45° FOV · 1932 by 1932 pixels.
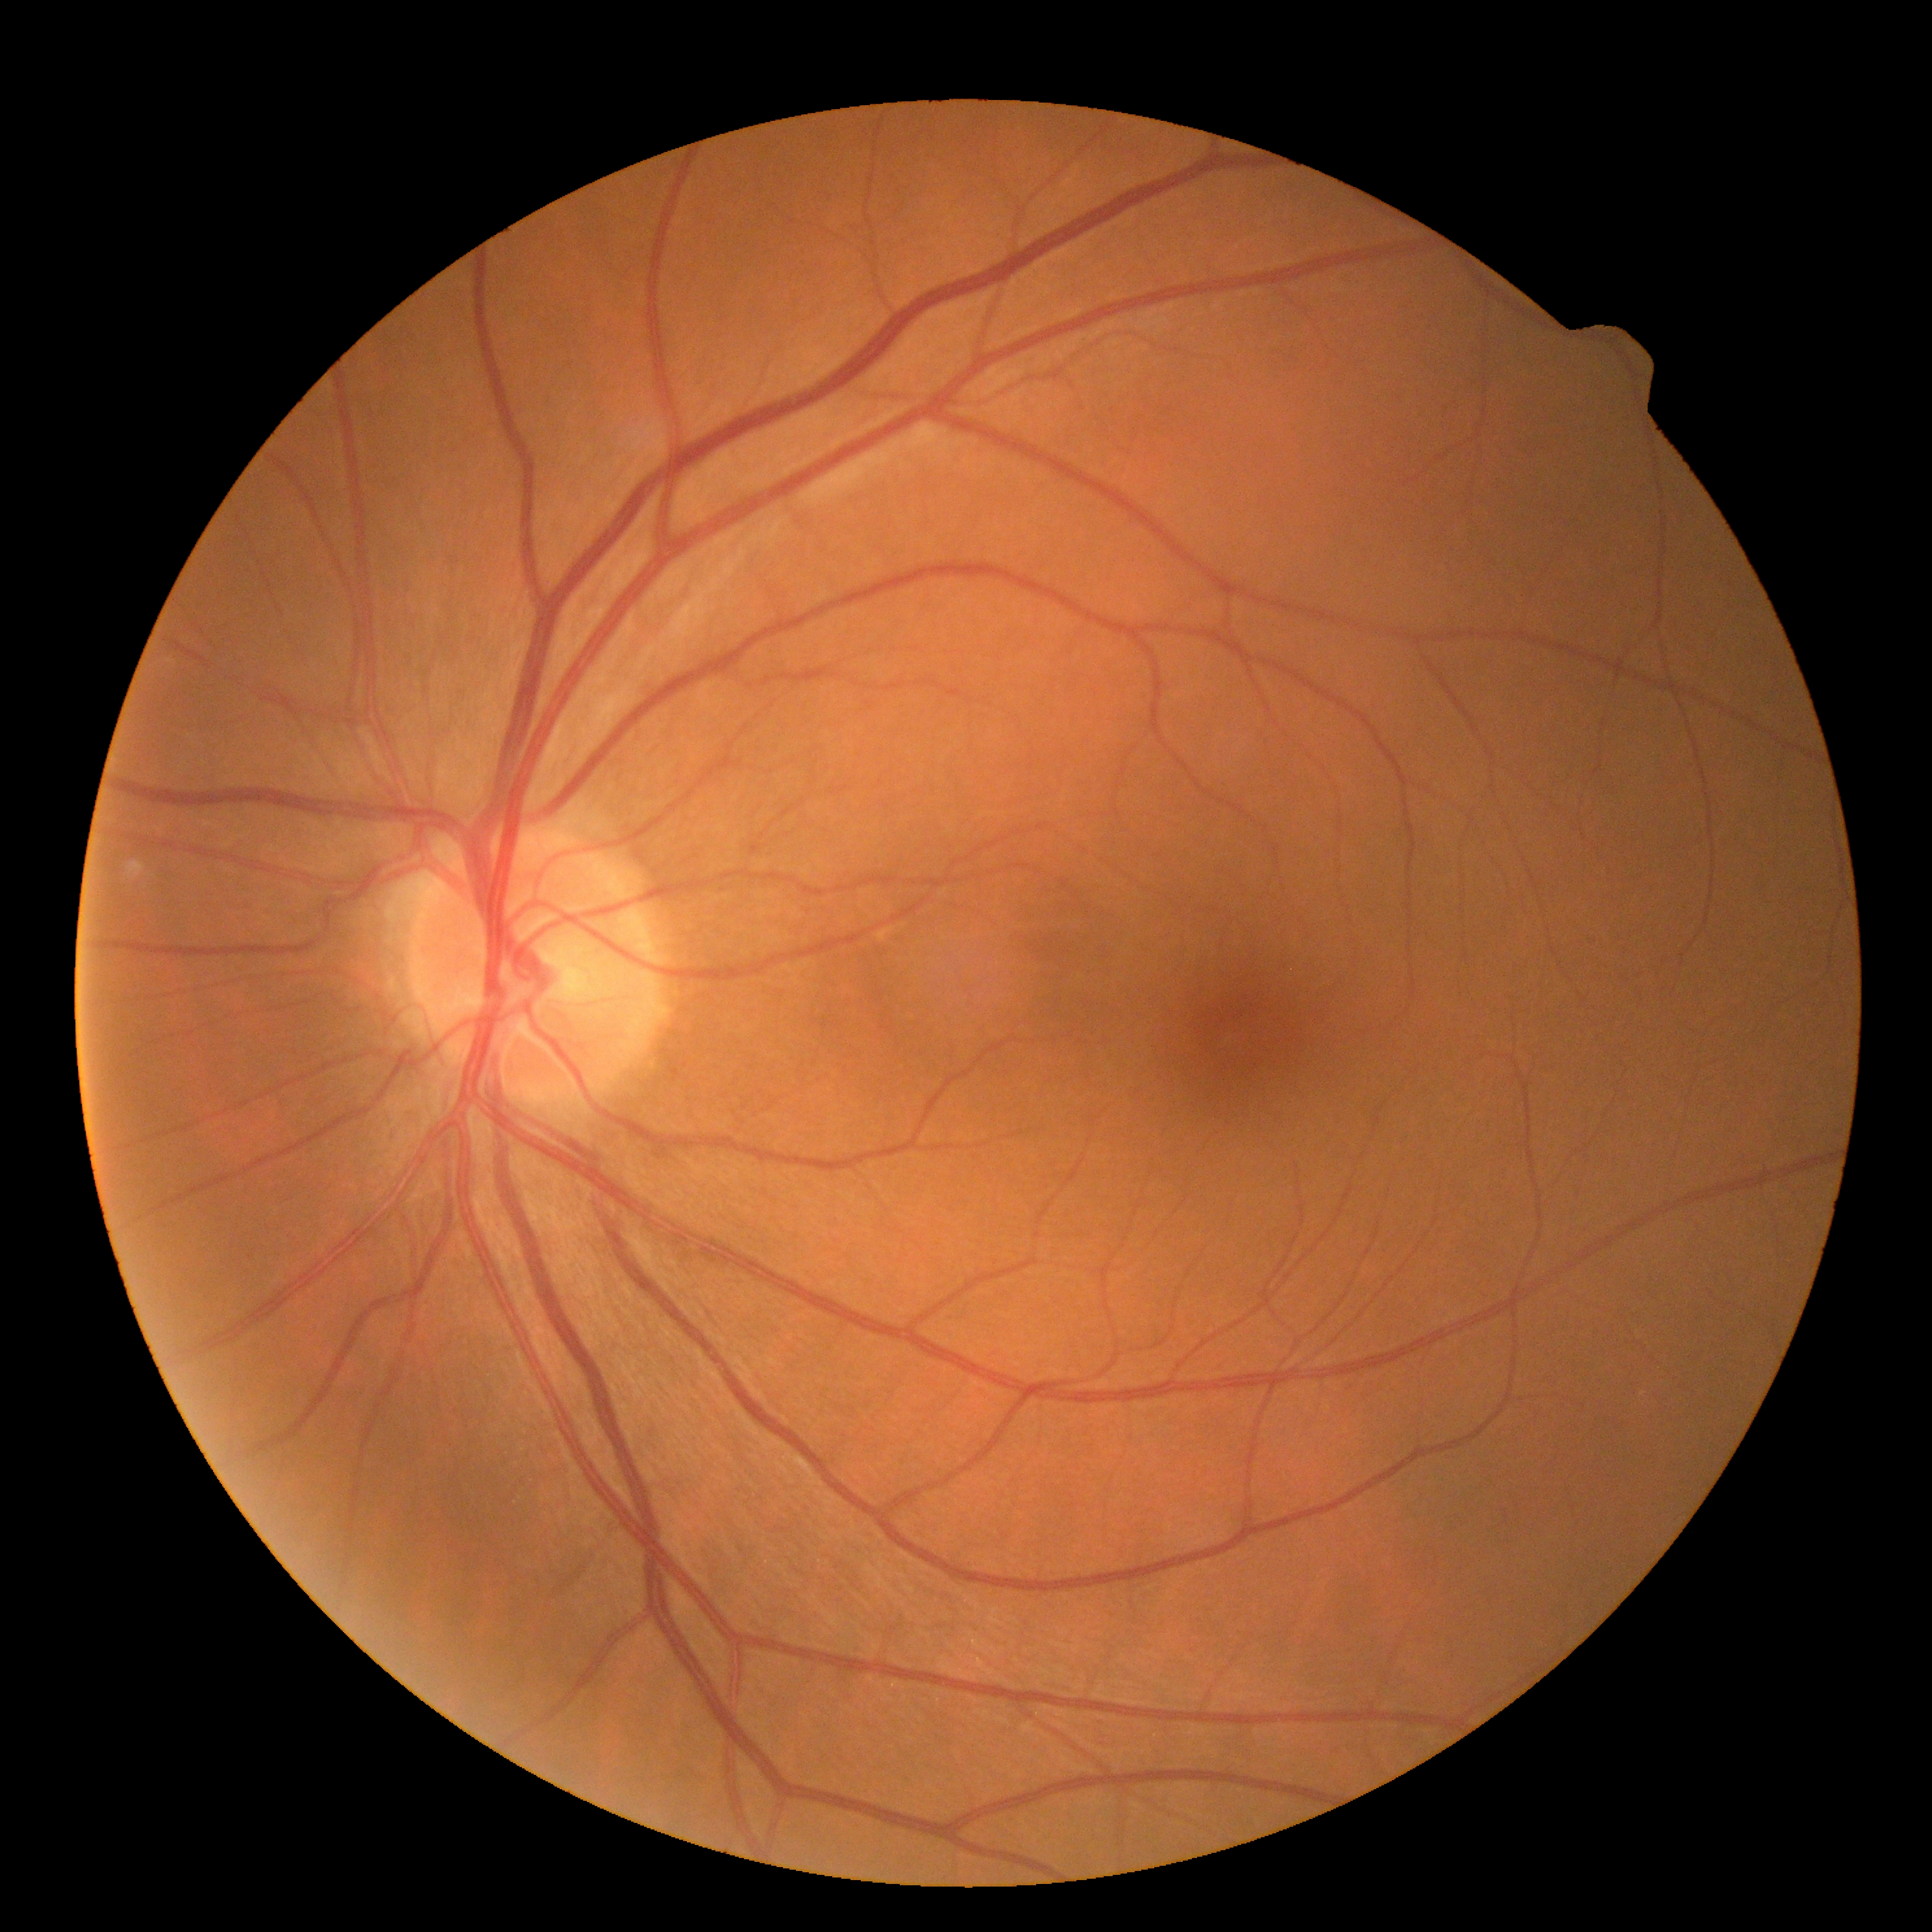

DR stage: 0.